Color fundus image.
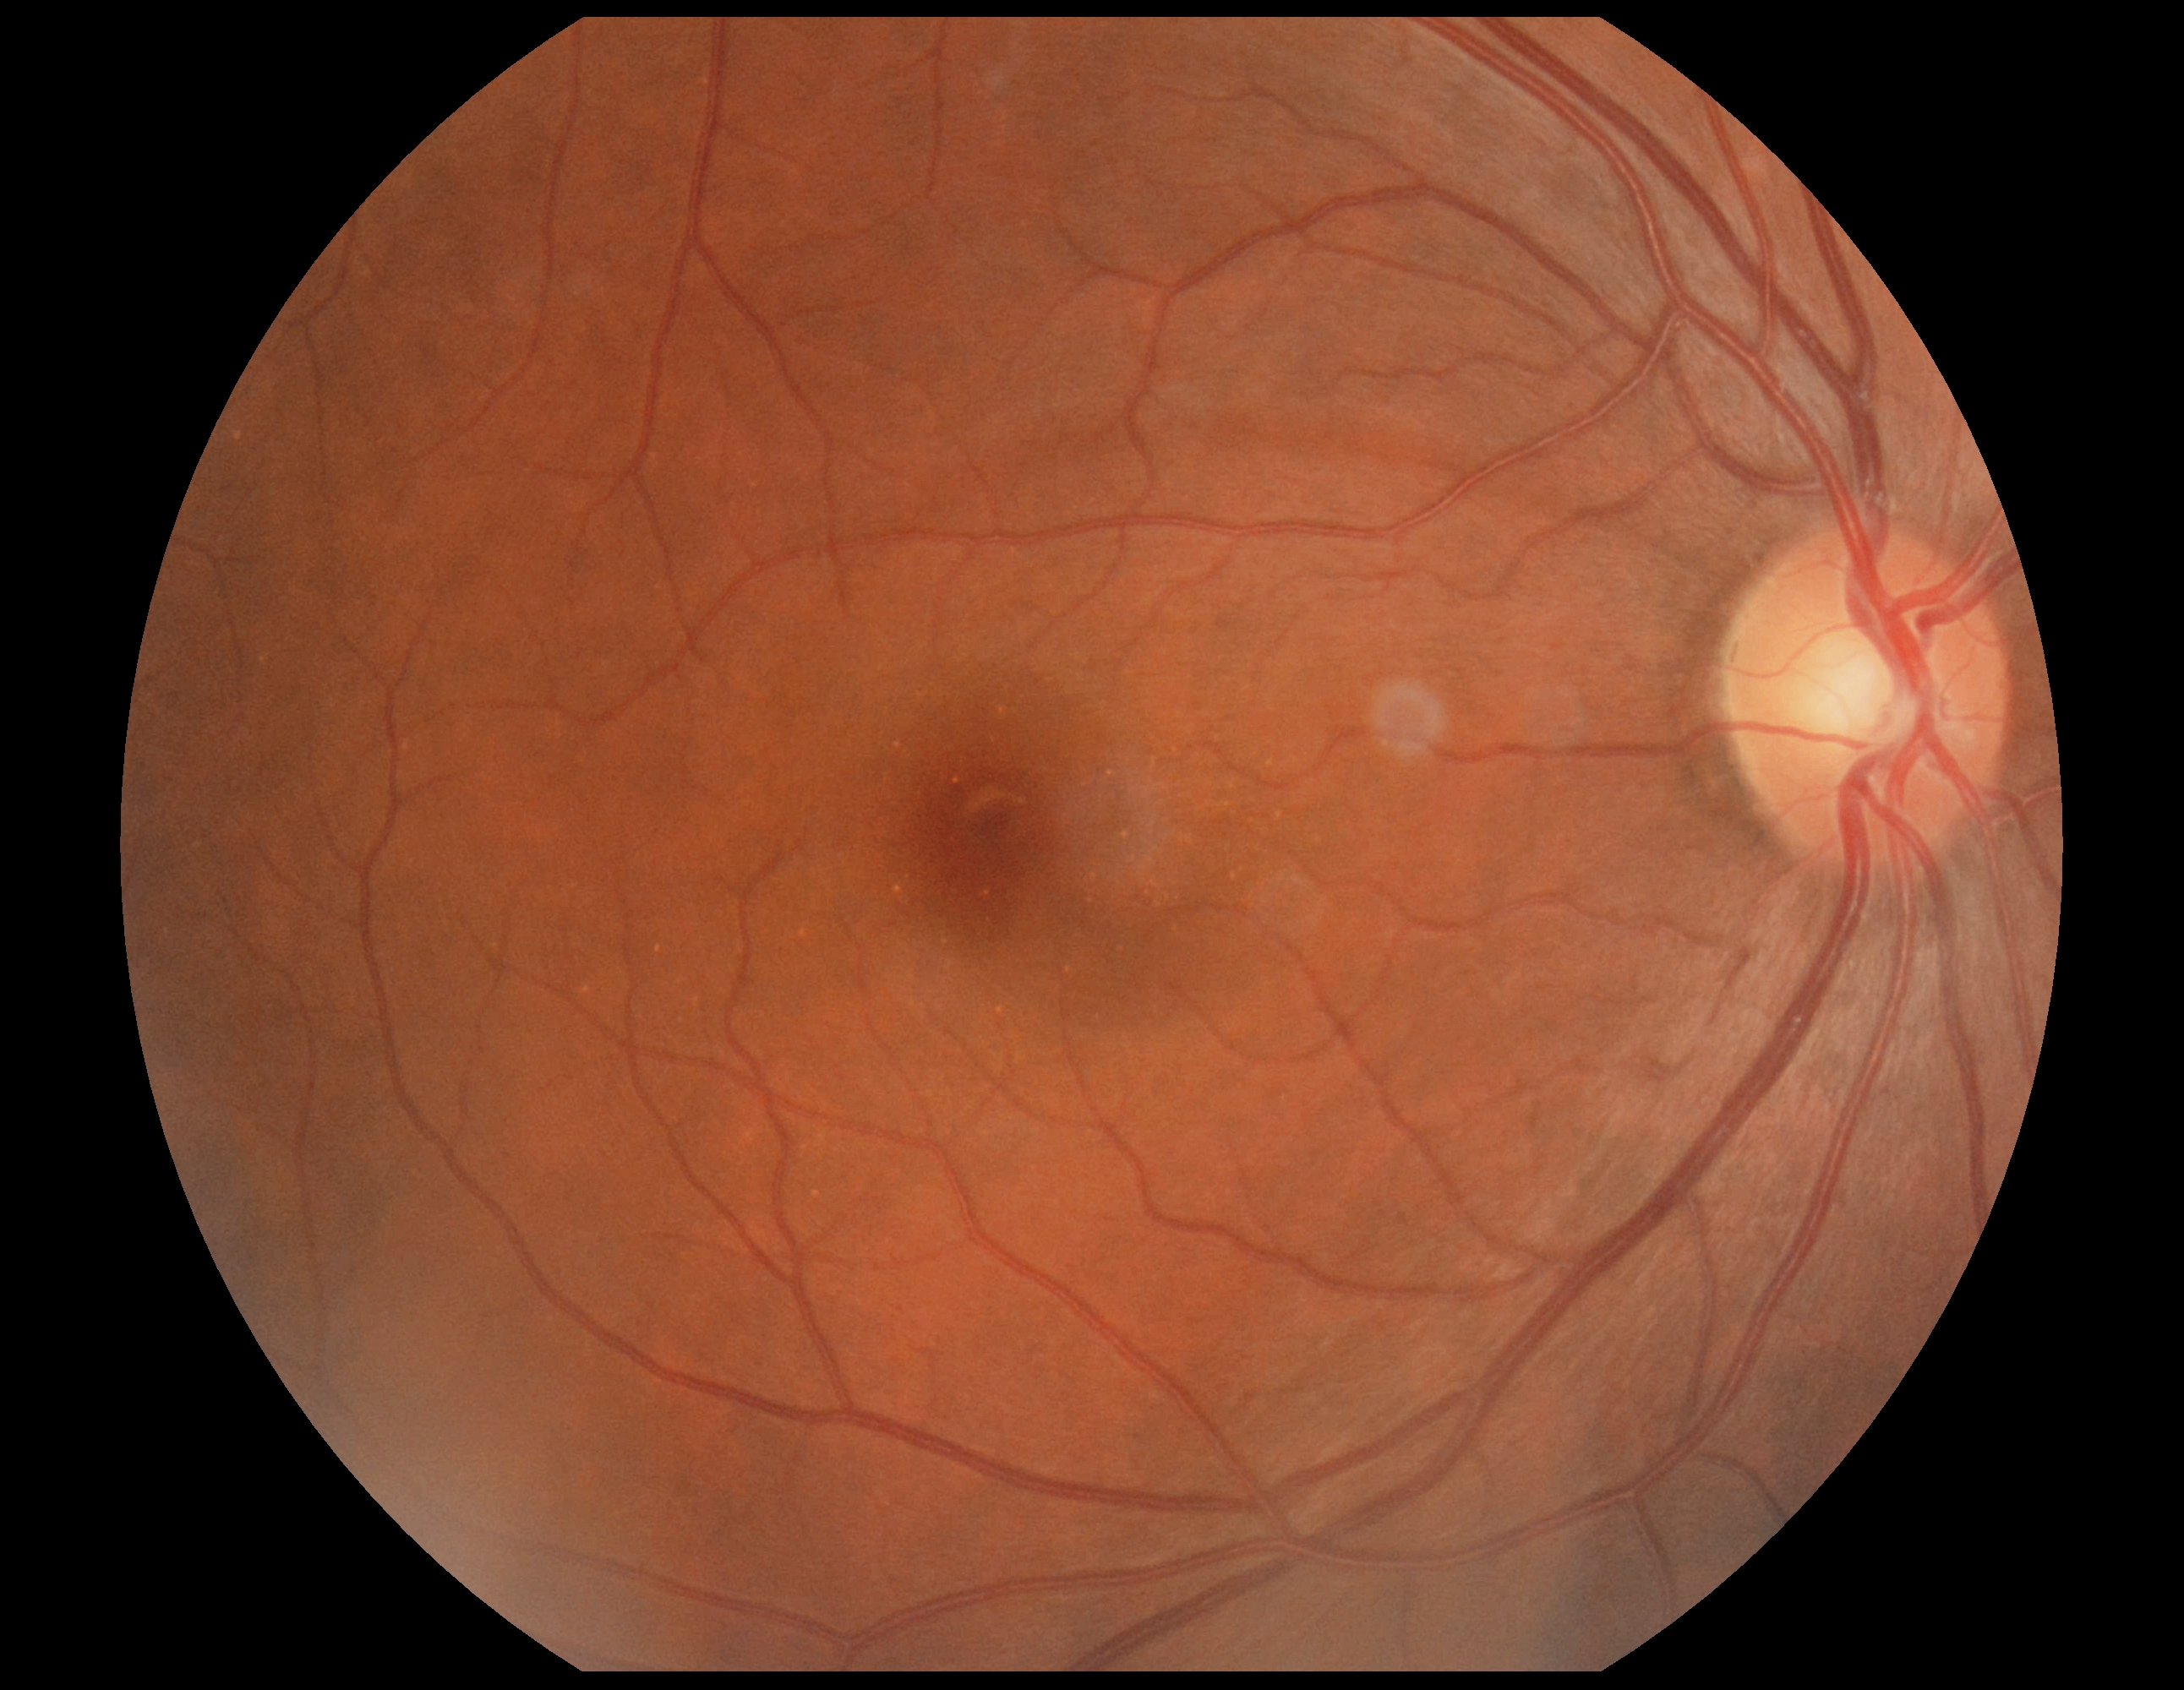 Diabetic retinopathy (DR): no apparent retinopathy (grade 0).